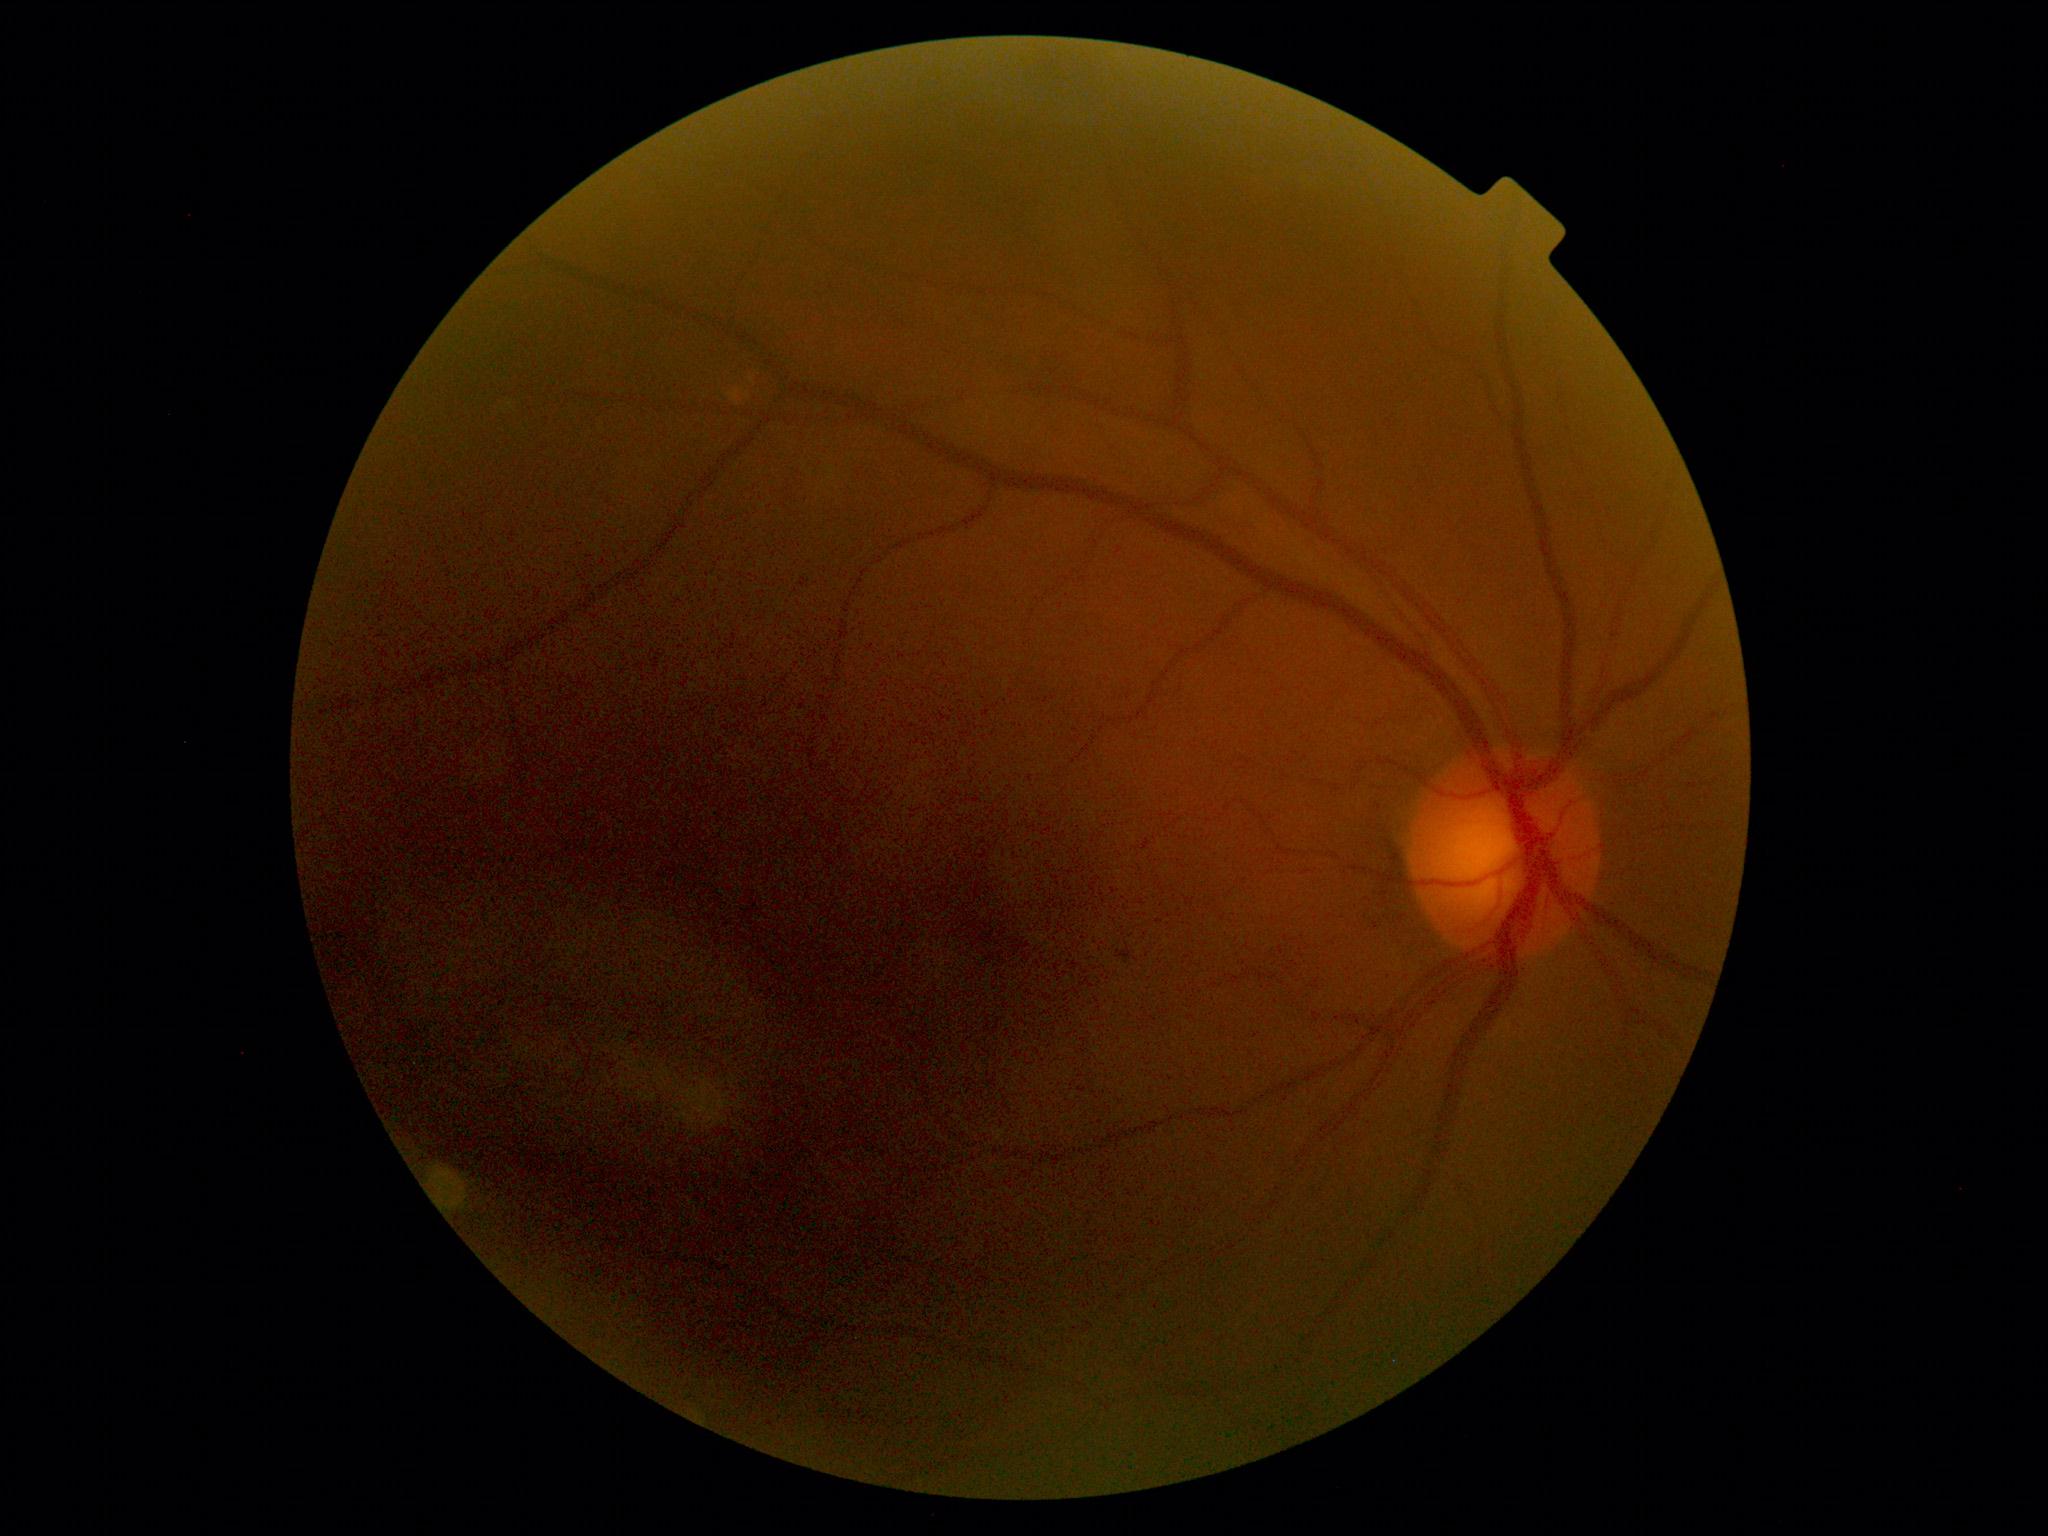 Findings:
- DR: 1/4